45° field of view, 2352 by 1568 pixels: 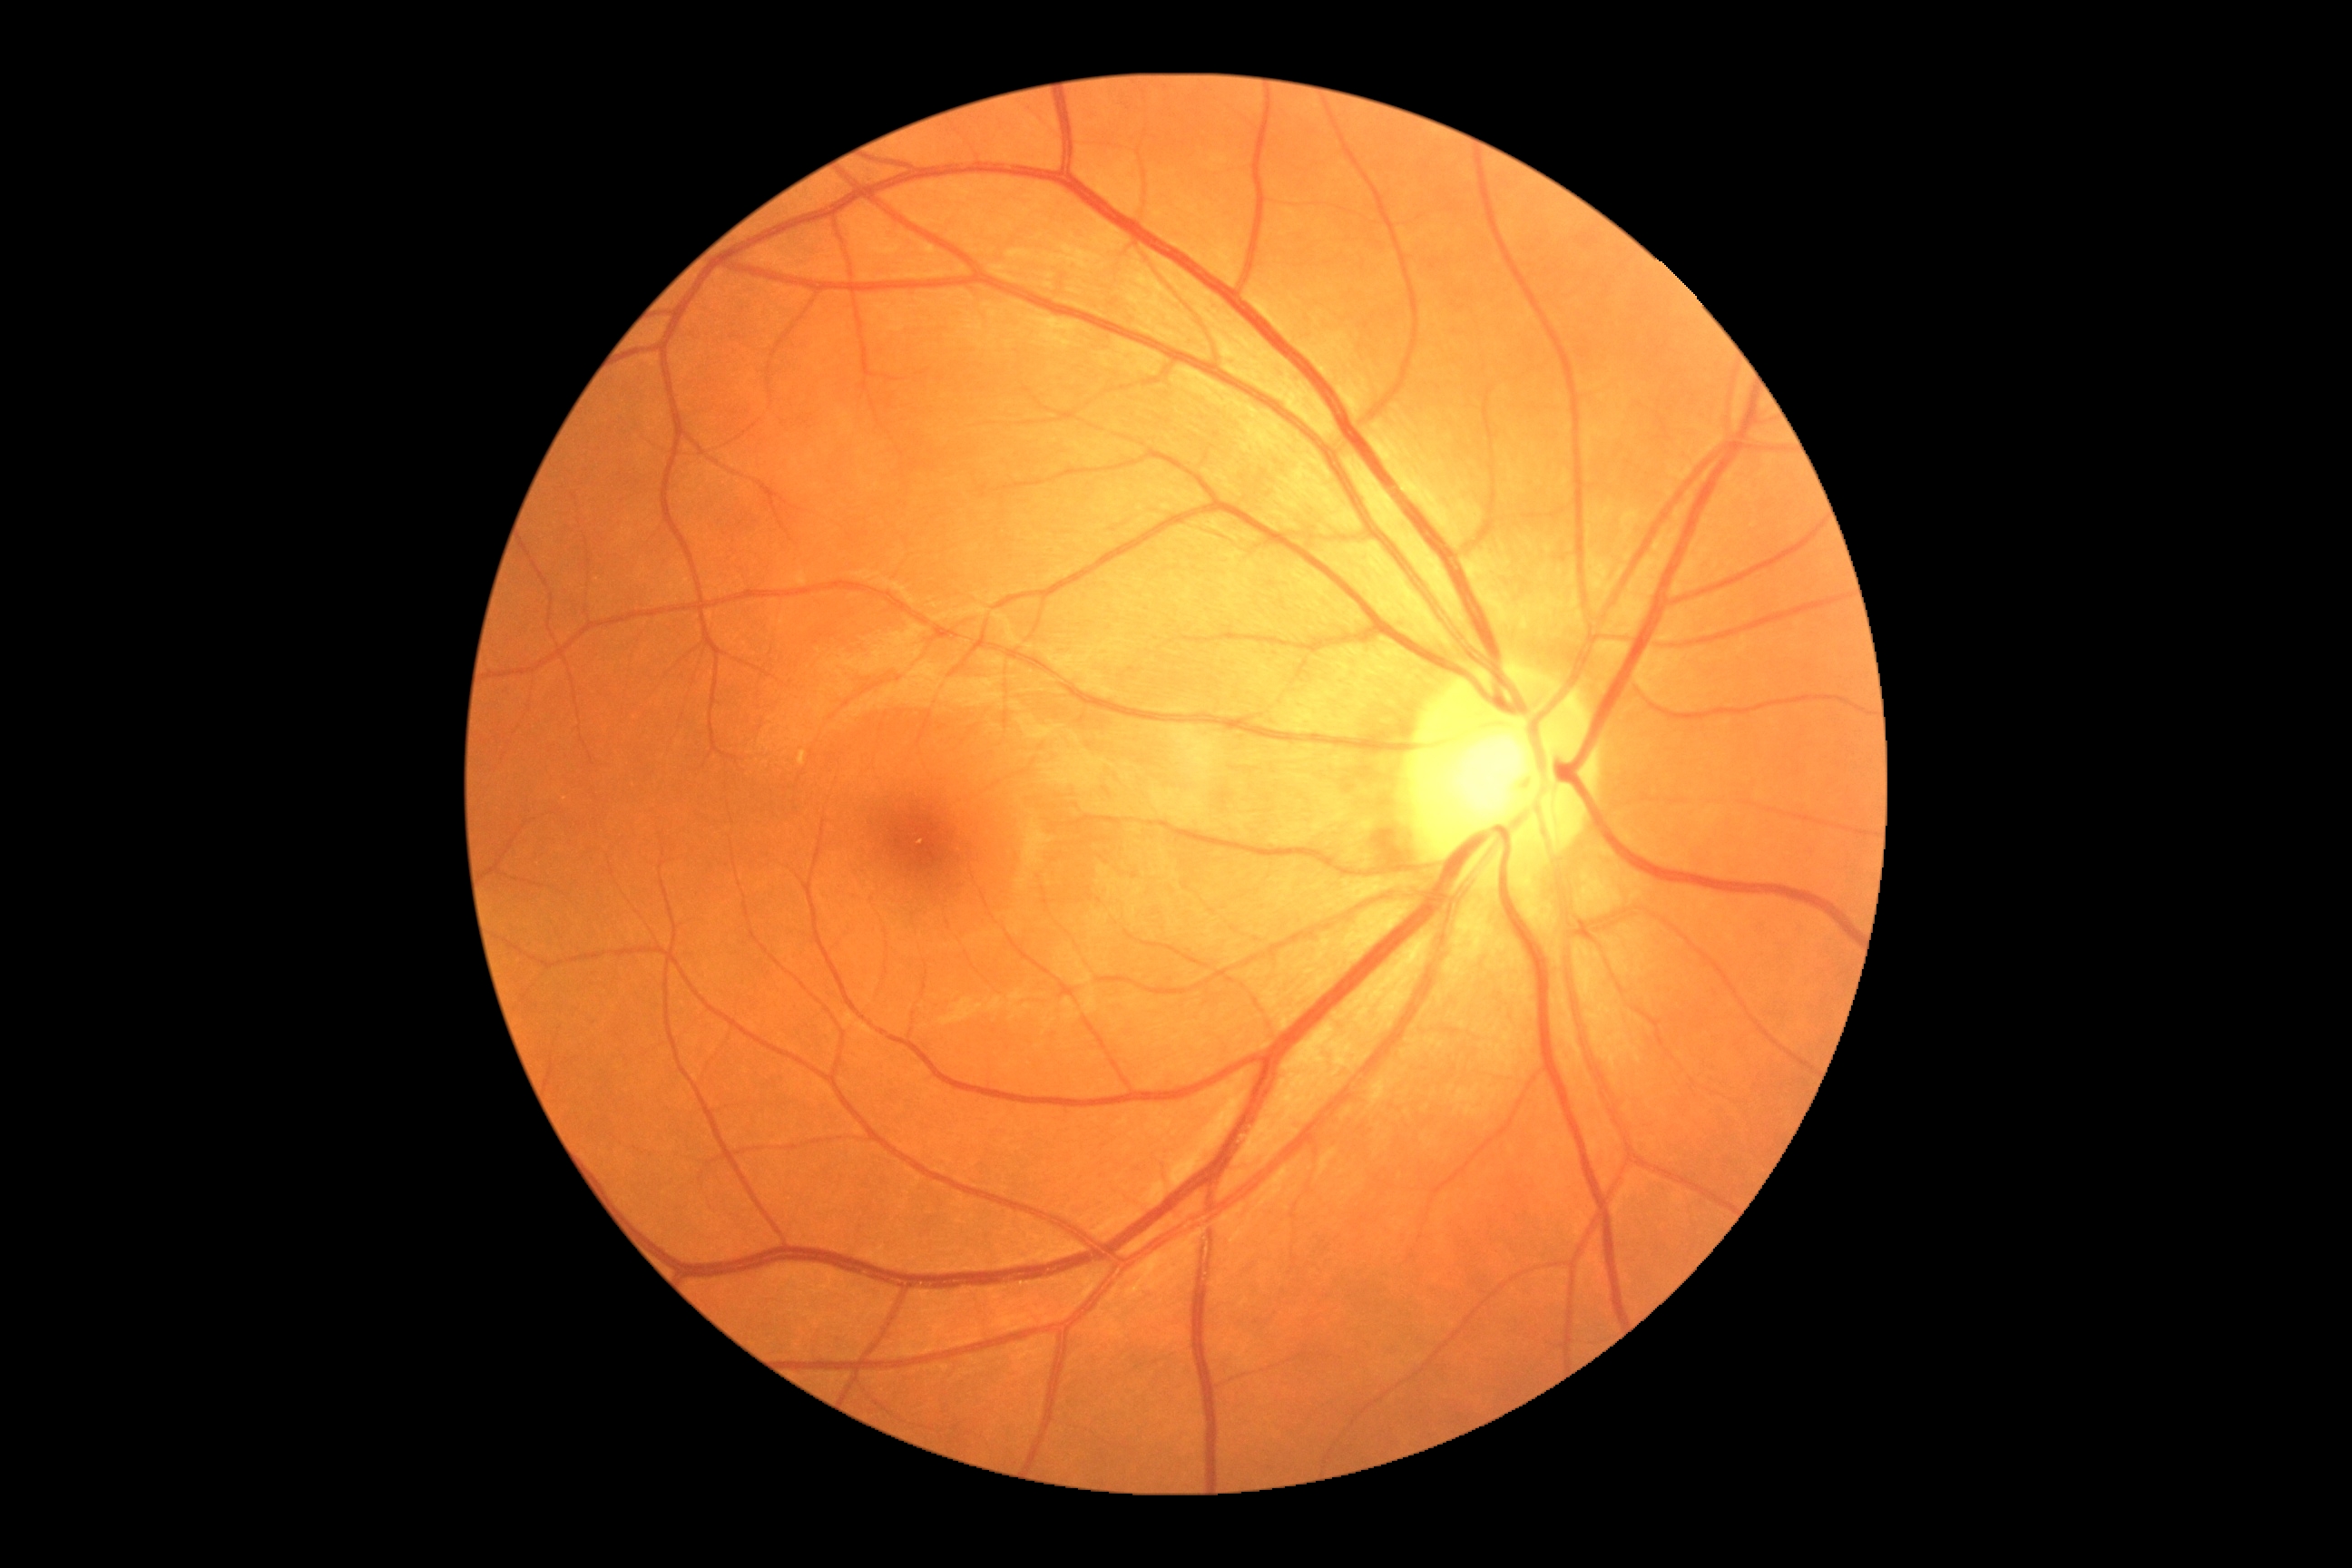
DR grade: 0.